Davis DR grading · image size 848x848 · CFP · 45-degree field of view · camera: NIDEK AFC-230 · nonmydriatic: 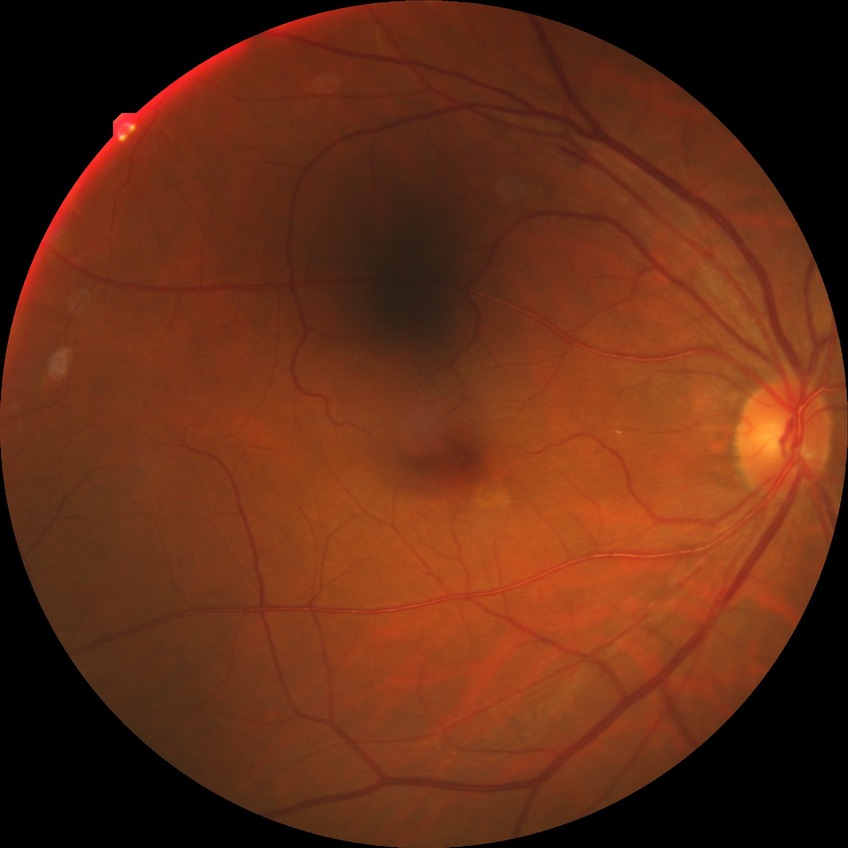

DR class: non-proliferative diabetic retinopathy; diabetic retinopathy (DR): simple diabetic retinopathy (SDR).